CFP; 1932 x 1910 pixels; 45° field of view:
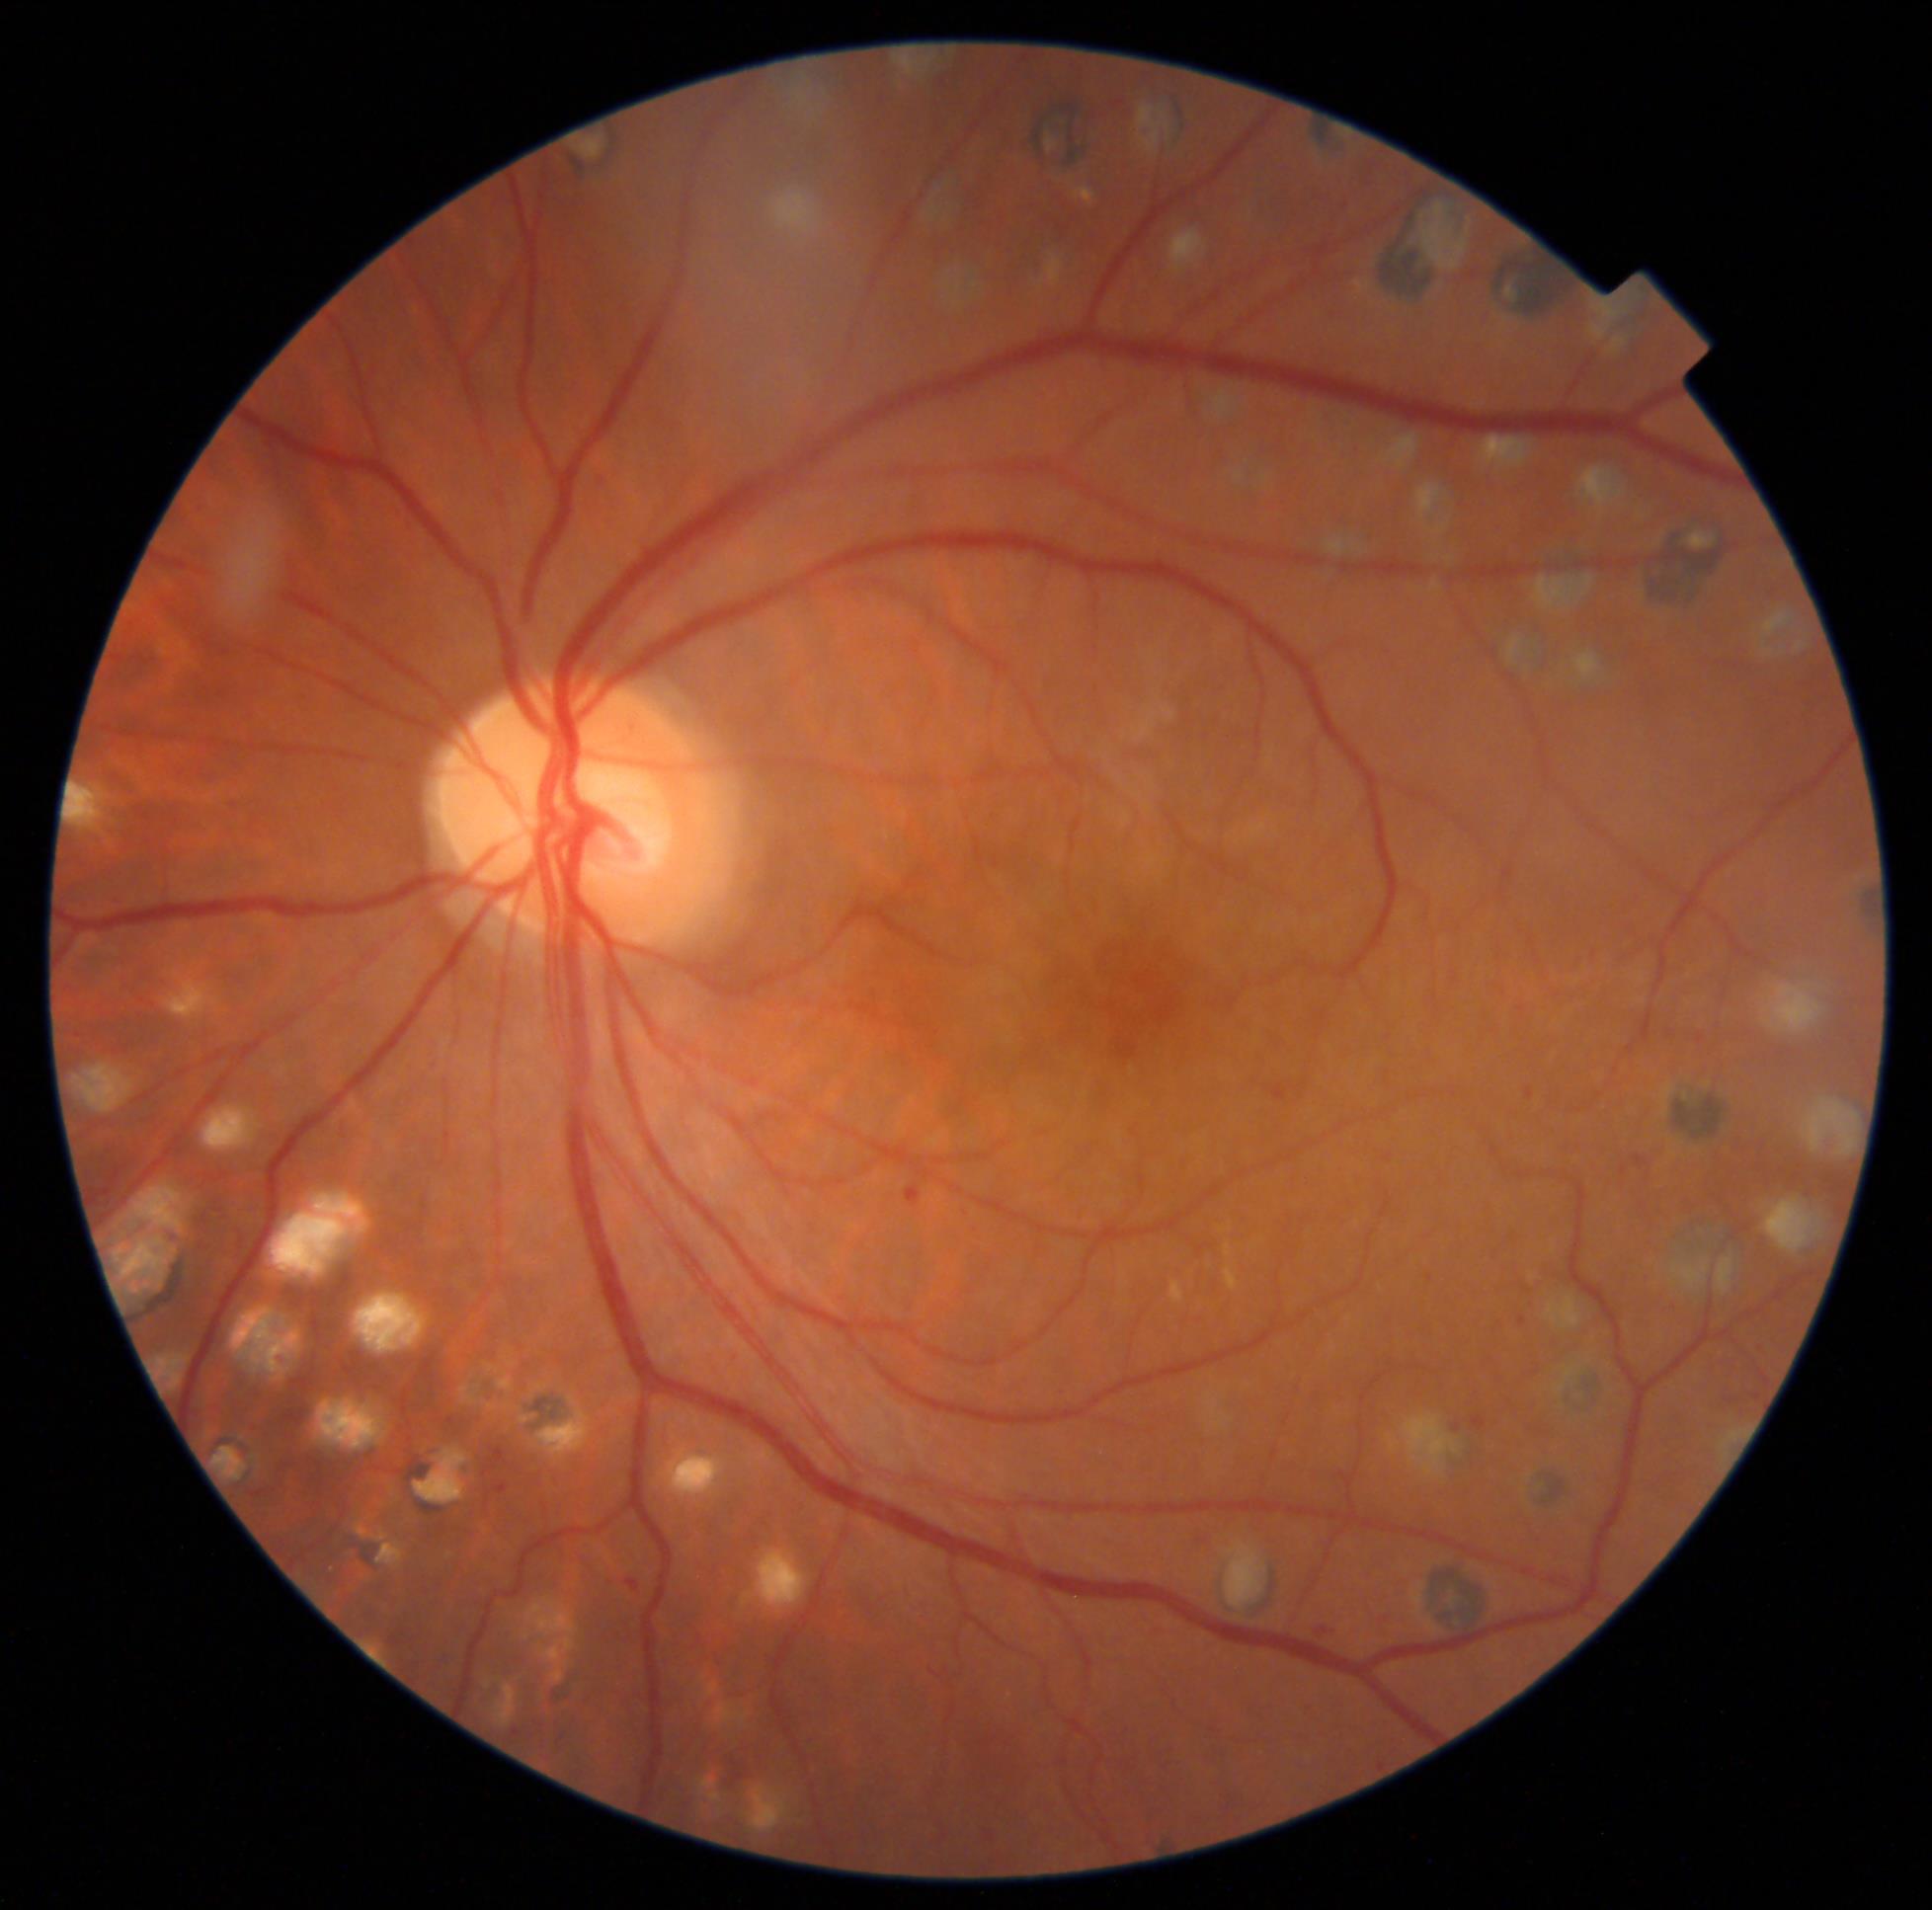 Diabetic retinopathy (DR): grade 2 (moderate NPDR).
Disease class: non-proliferative diabetic retinopathy.